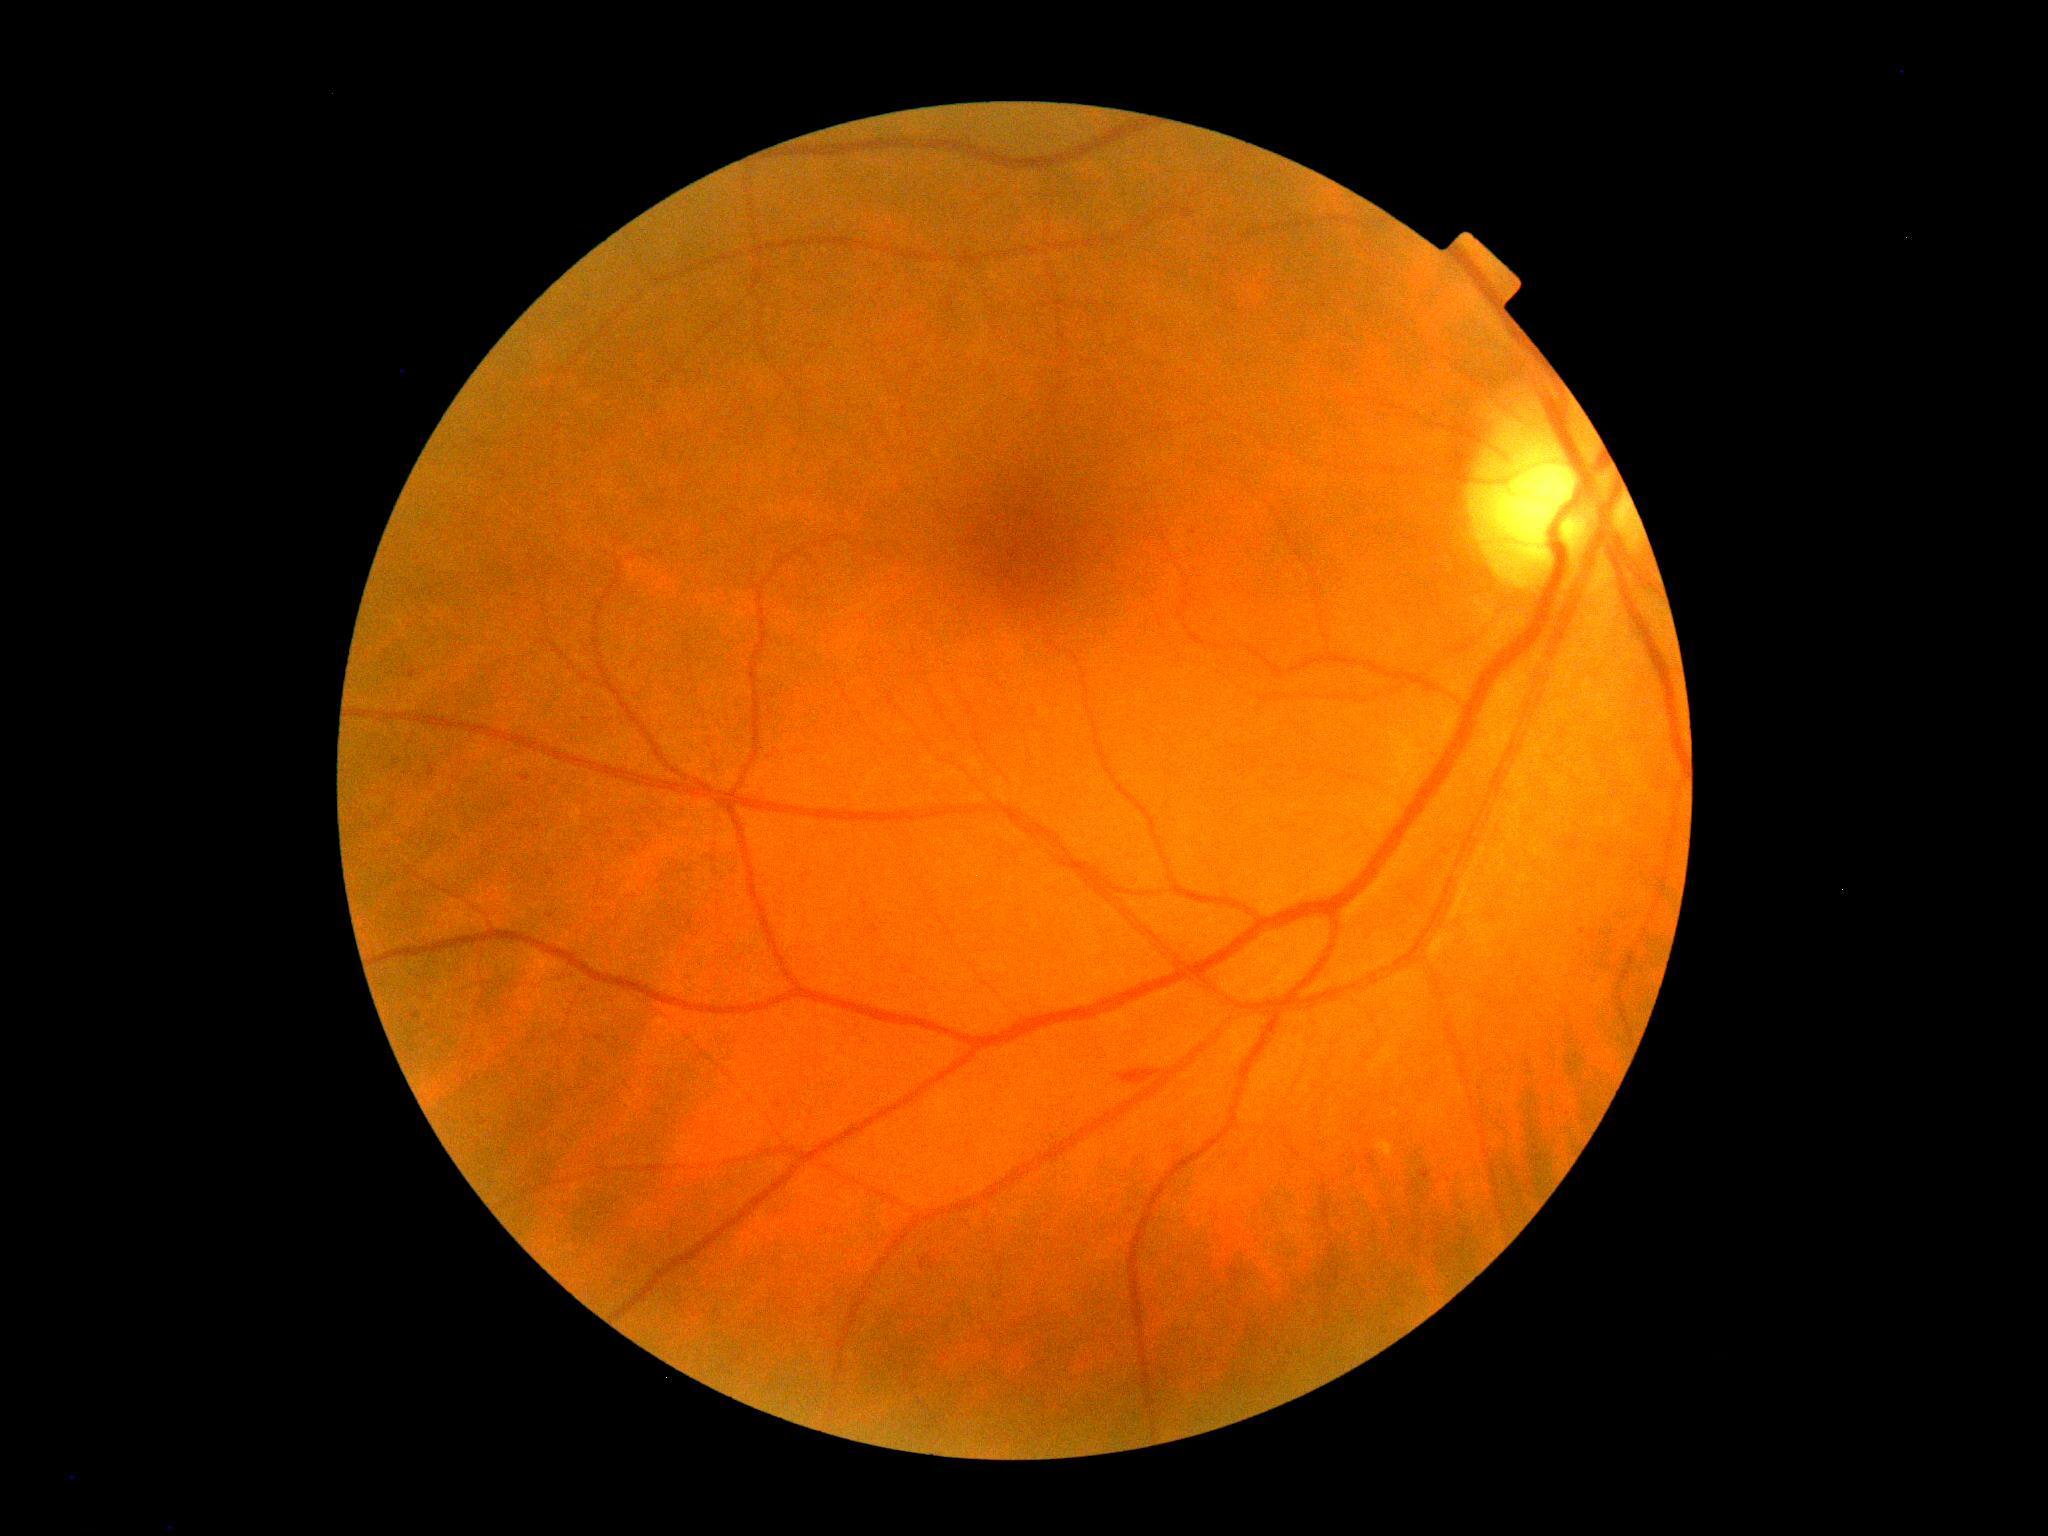
DR severity = 2 | DR class = non-proliferative diabetic retinopathy.